Acquired with a Topcon TRC-50DX. 2228x1652
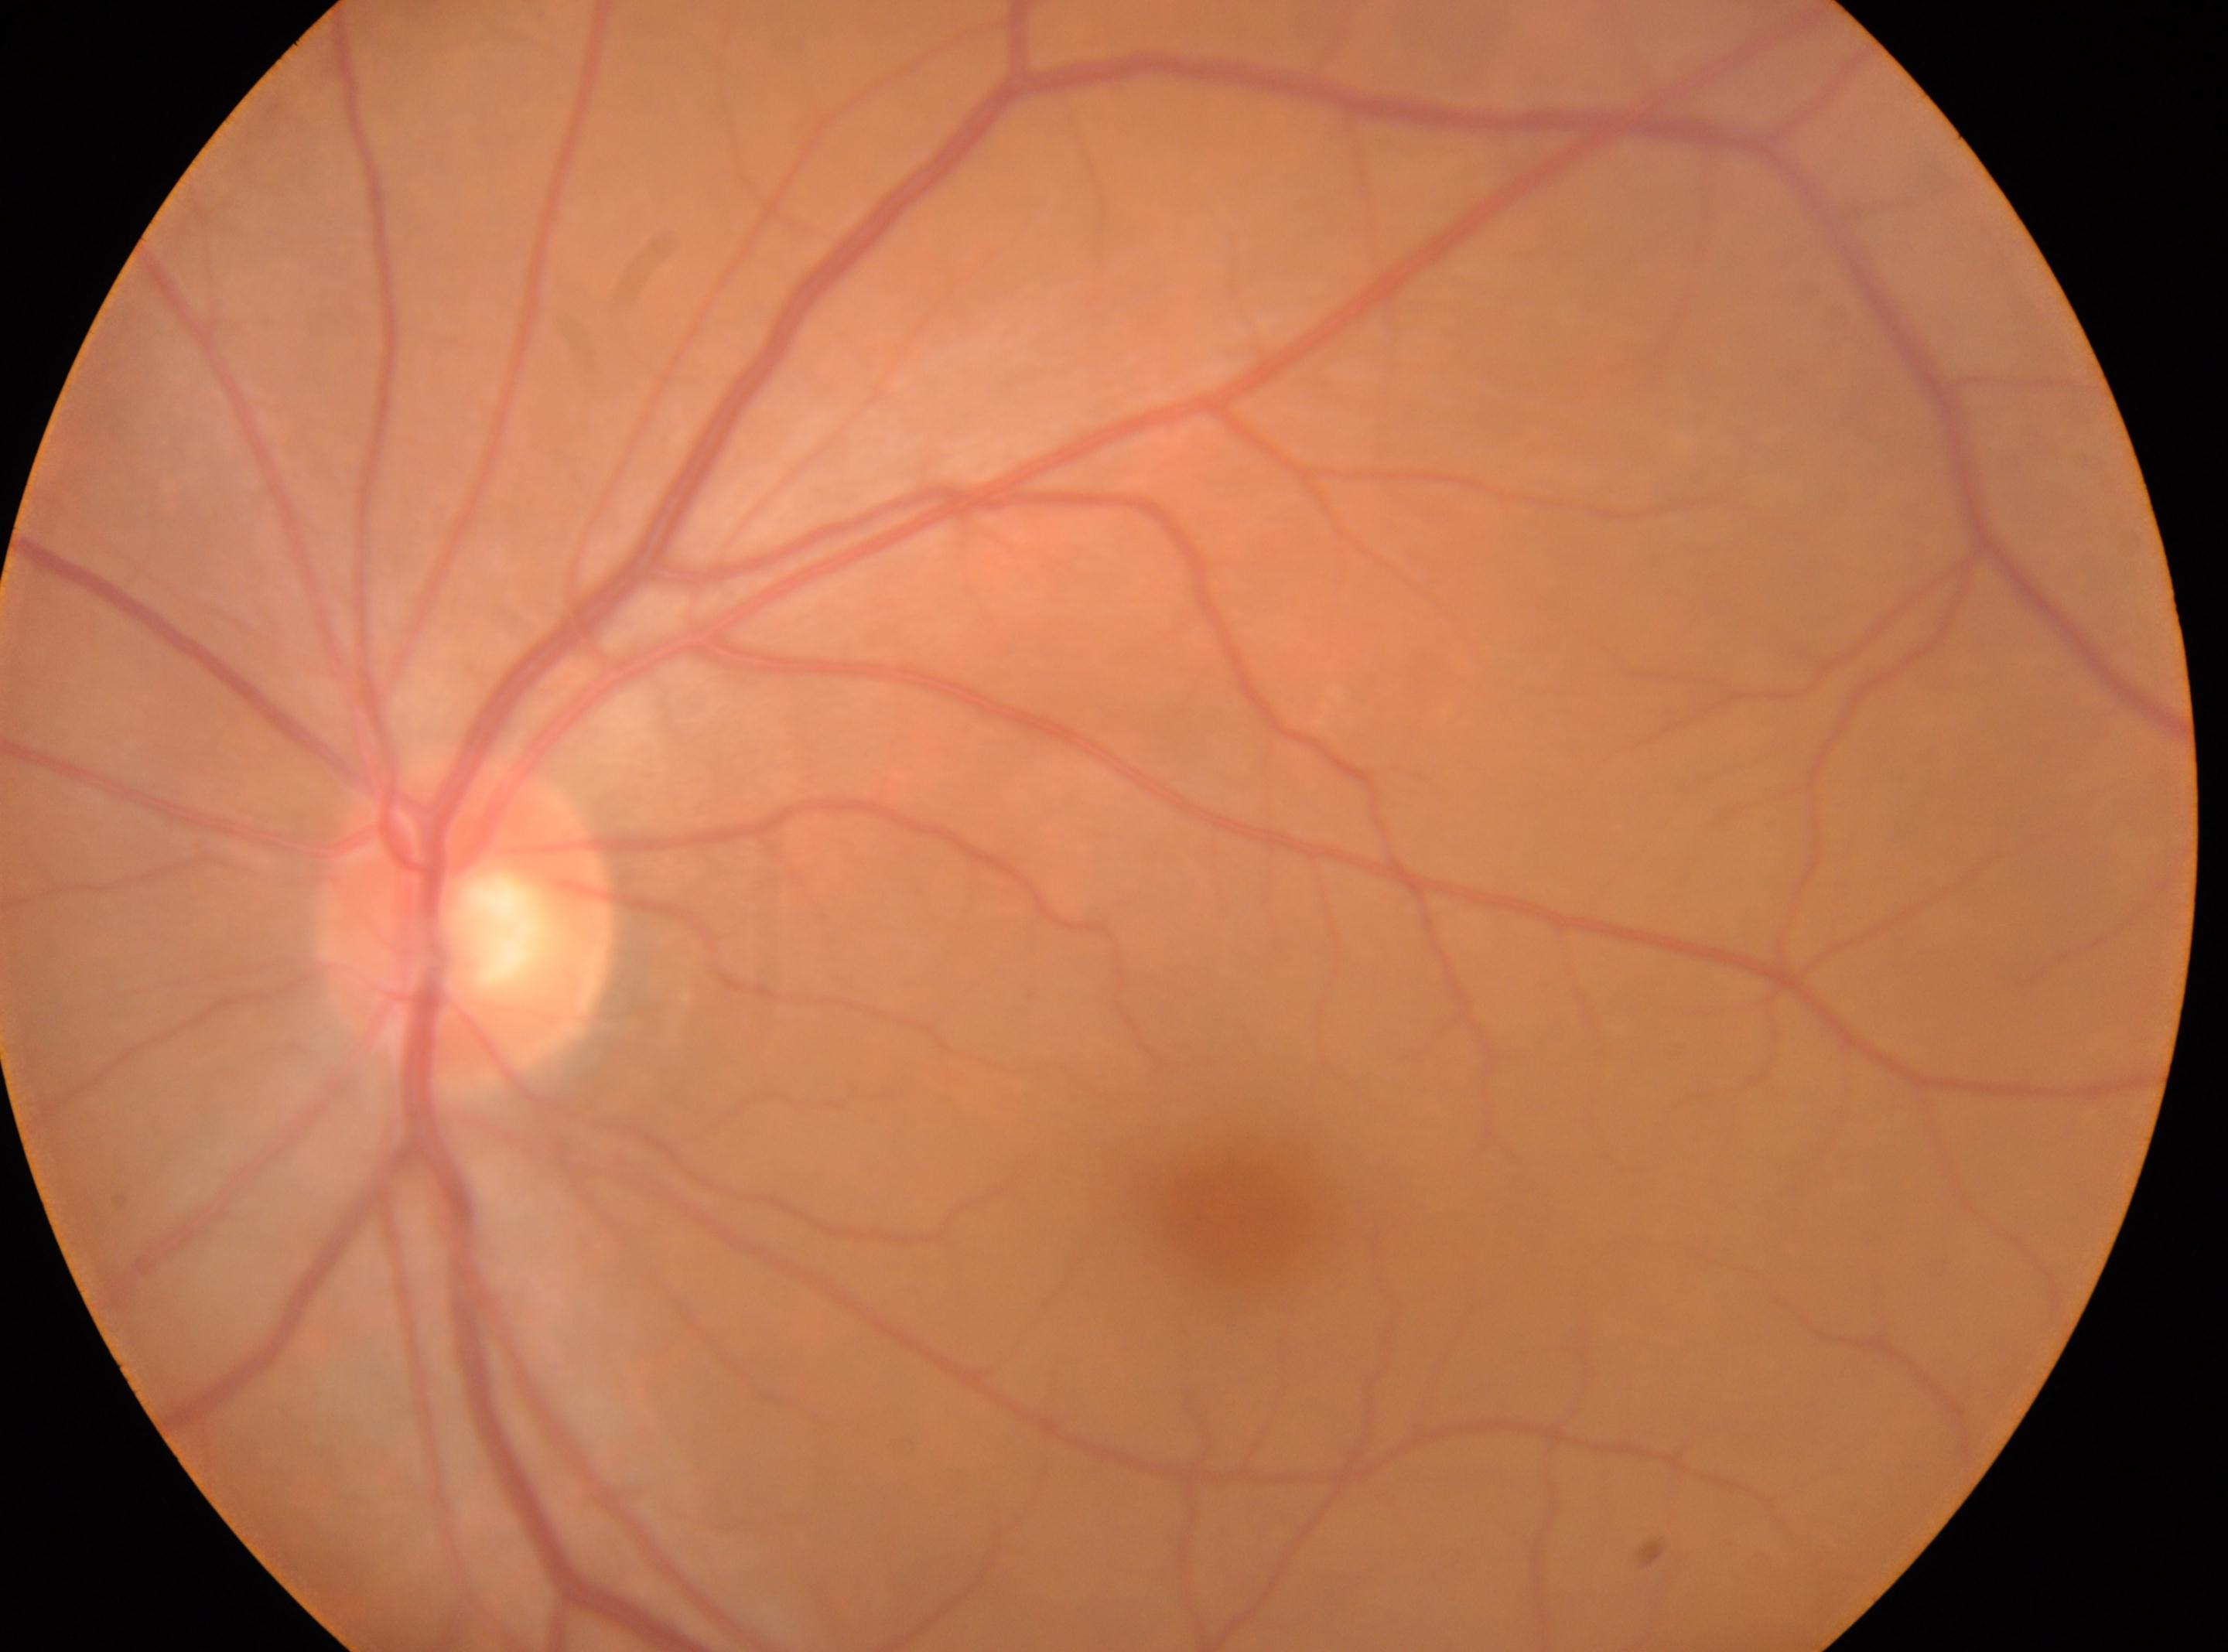 DR is no apparent diabetic retinopathy (grade 0).
Disc center: 466, 927.
Imaged eye: OS.
Fovea center located at 1242, 1213.